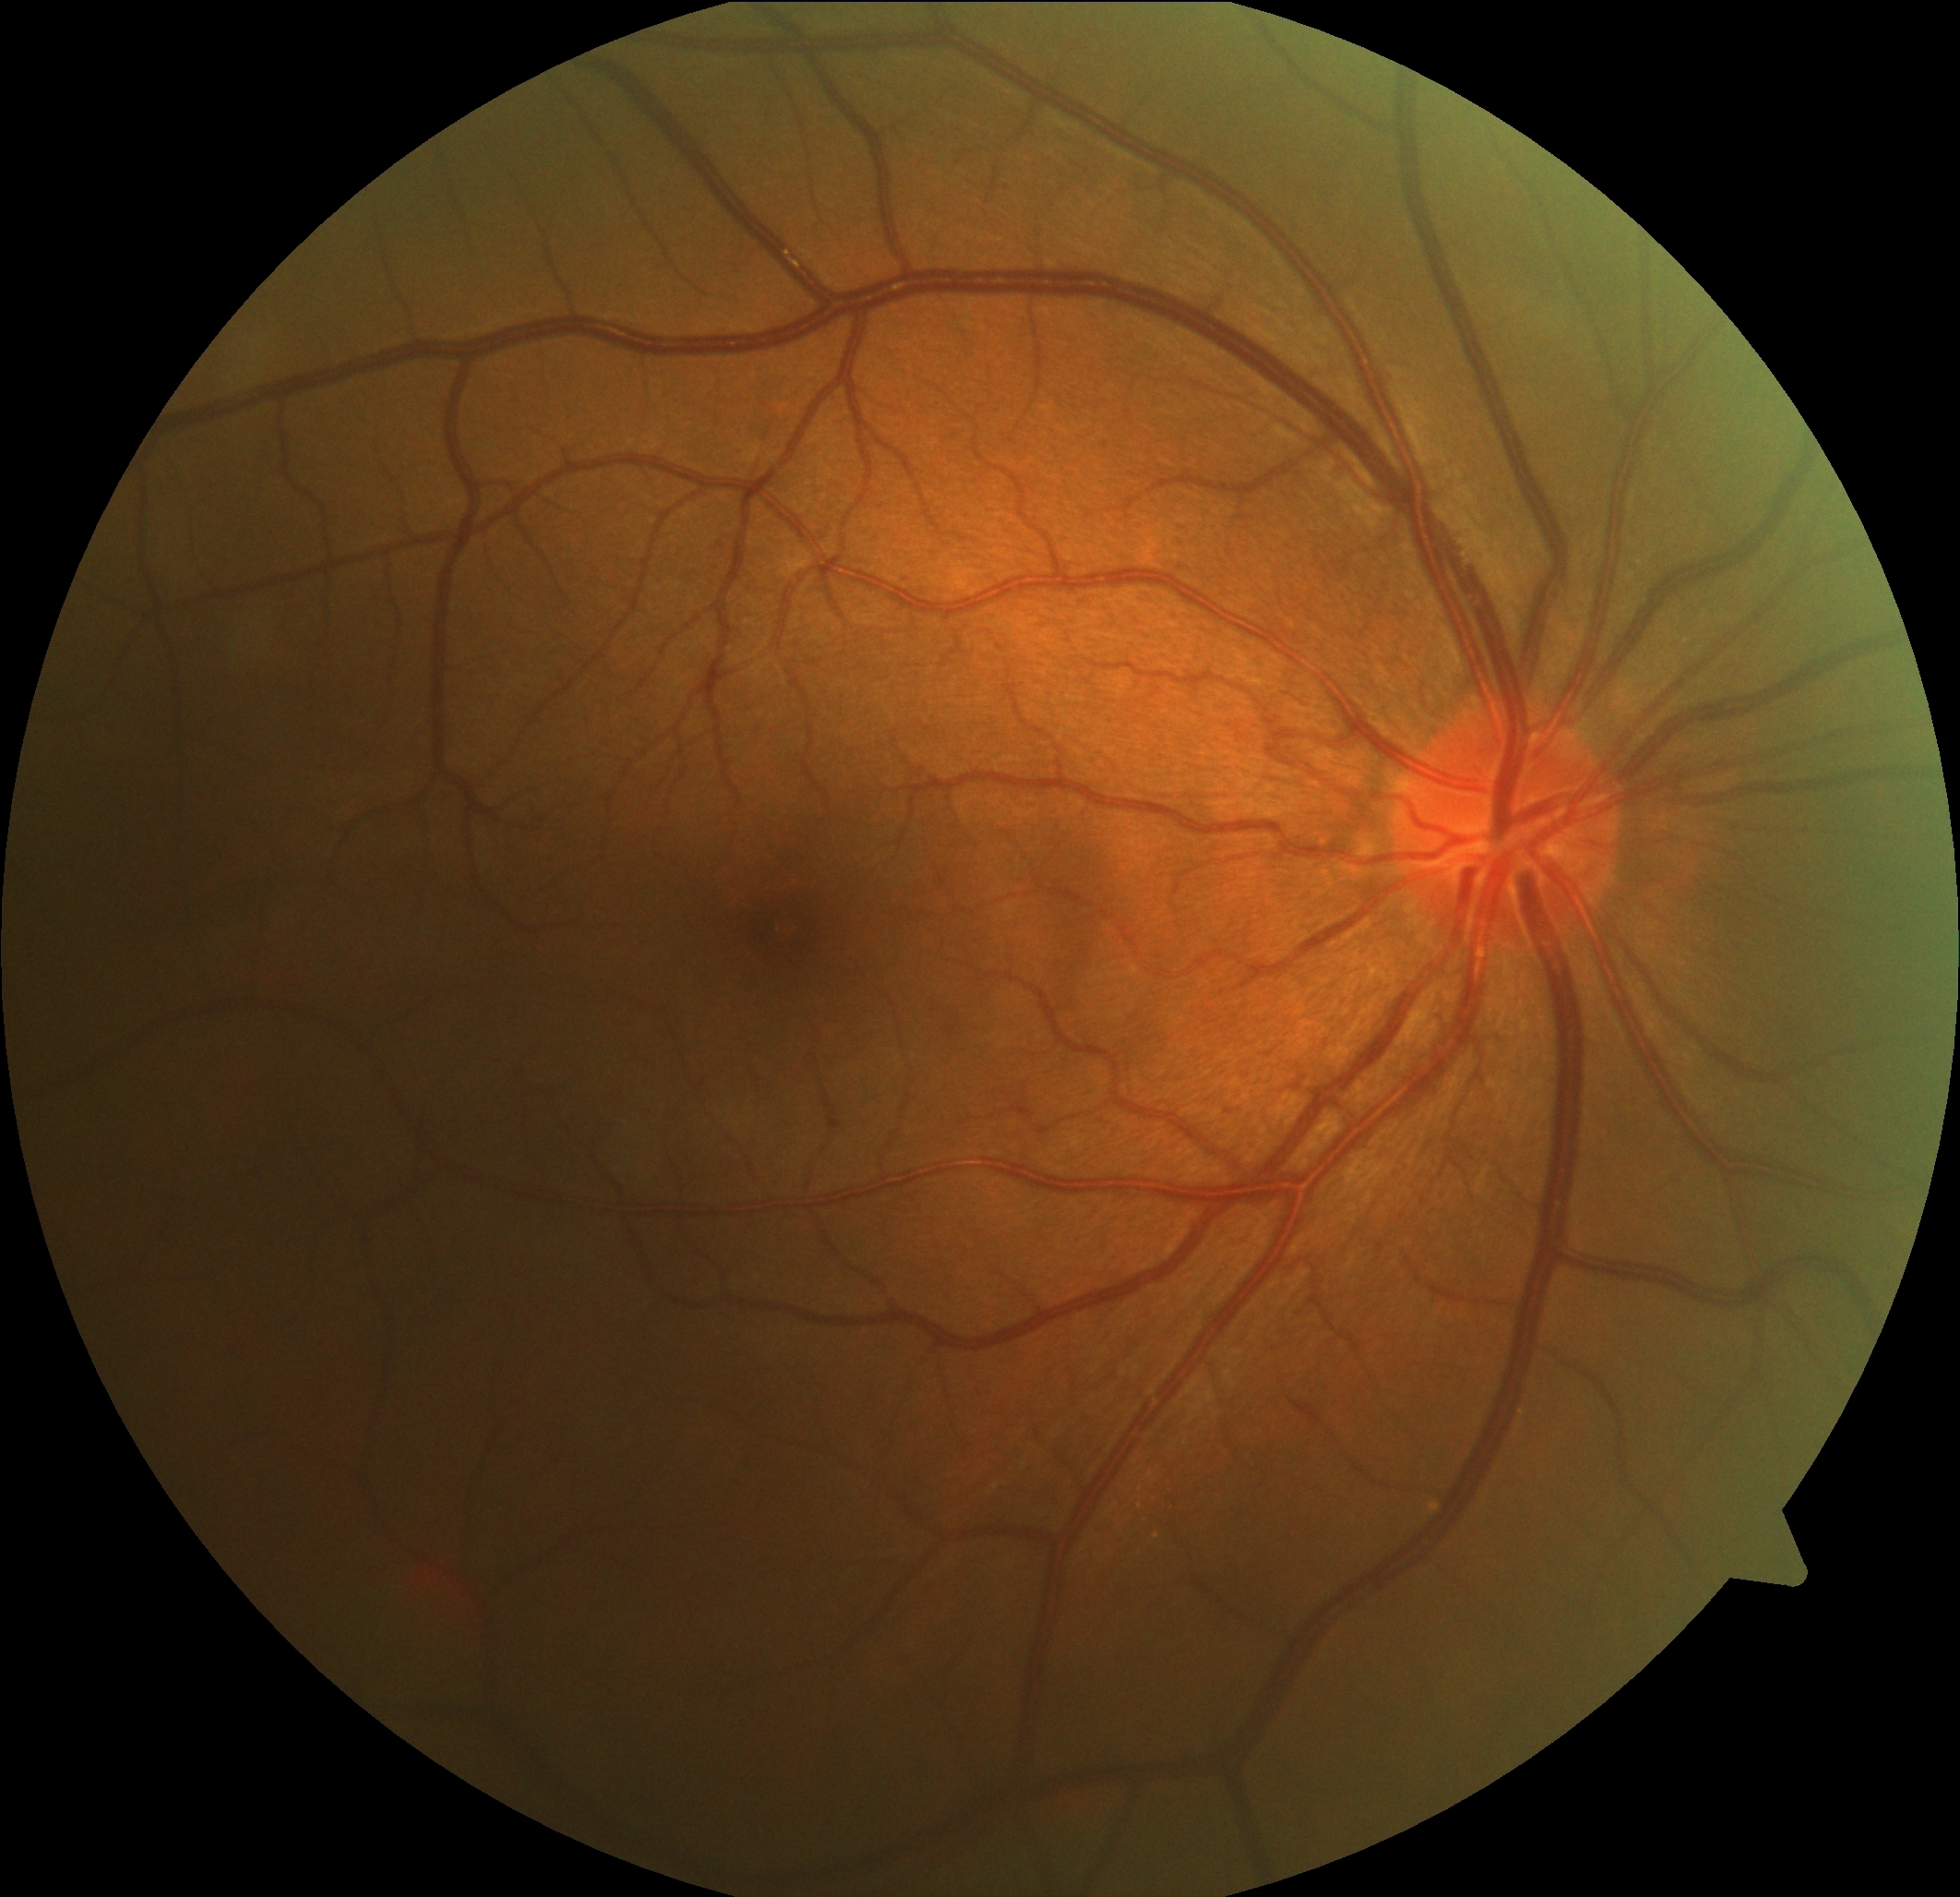 DR severity: 0/4.